Fundus photo — 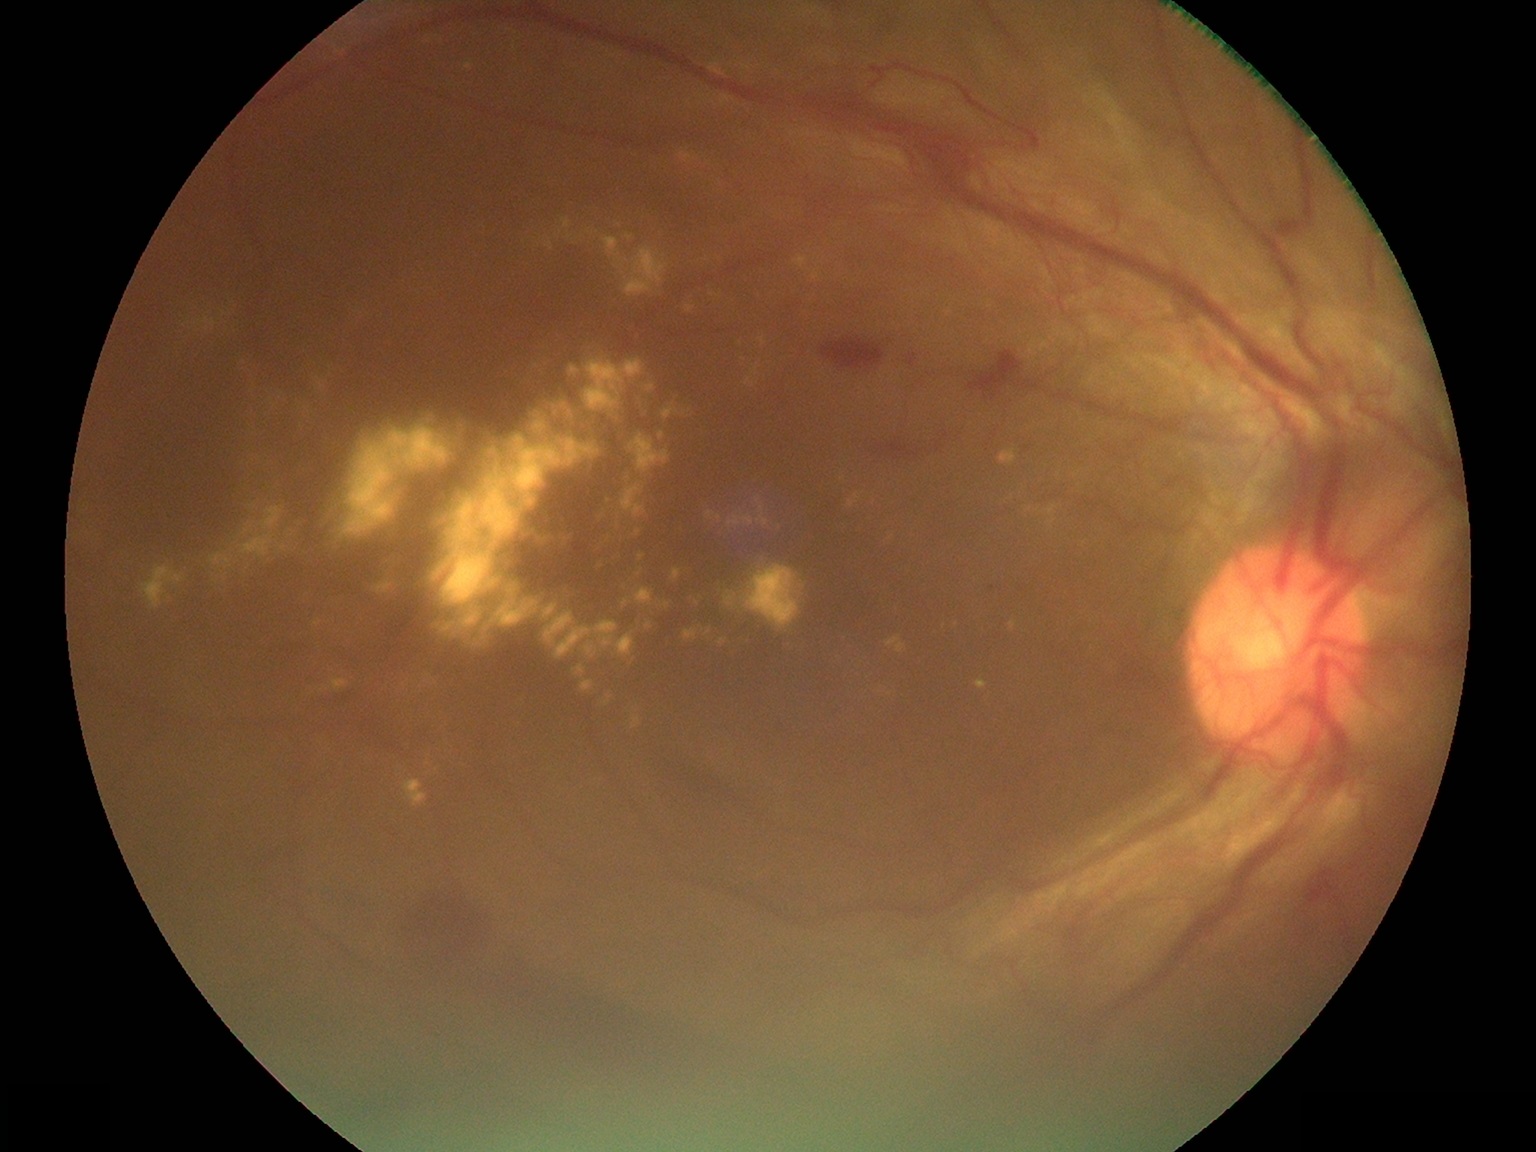

<lesions partial="true">
  <dr_grade>4</dr_grade>
  <ex partial="true">(745, 377, 760, 388); (615, 632, 636, 658); (329, 366, 335, 377); (1042, 505, 1057, 529); (626, 236, 635, 241); (670, 567, 683, 582); (562, 218, 571, 230); (752, 364, 760, 376); (622, 597, 633, 608); (794, 255, 811, 270); (239, 506, 284, 560); (567, 231, 573, 241)</ex>
  <ex_small_approx>{"x": 879, "y": 691}; {"x": 1037, "y": 510}; {"x": 743, "y": 359}; {"x": 235, "y": 306}; {"x": 487, "y": 629}; {"x": 601, "y": 565}</ex_small_approx>
</lesions>